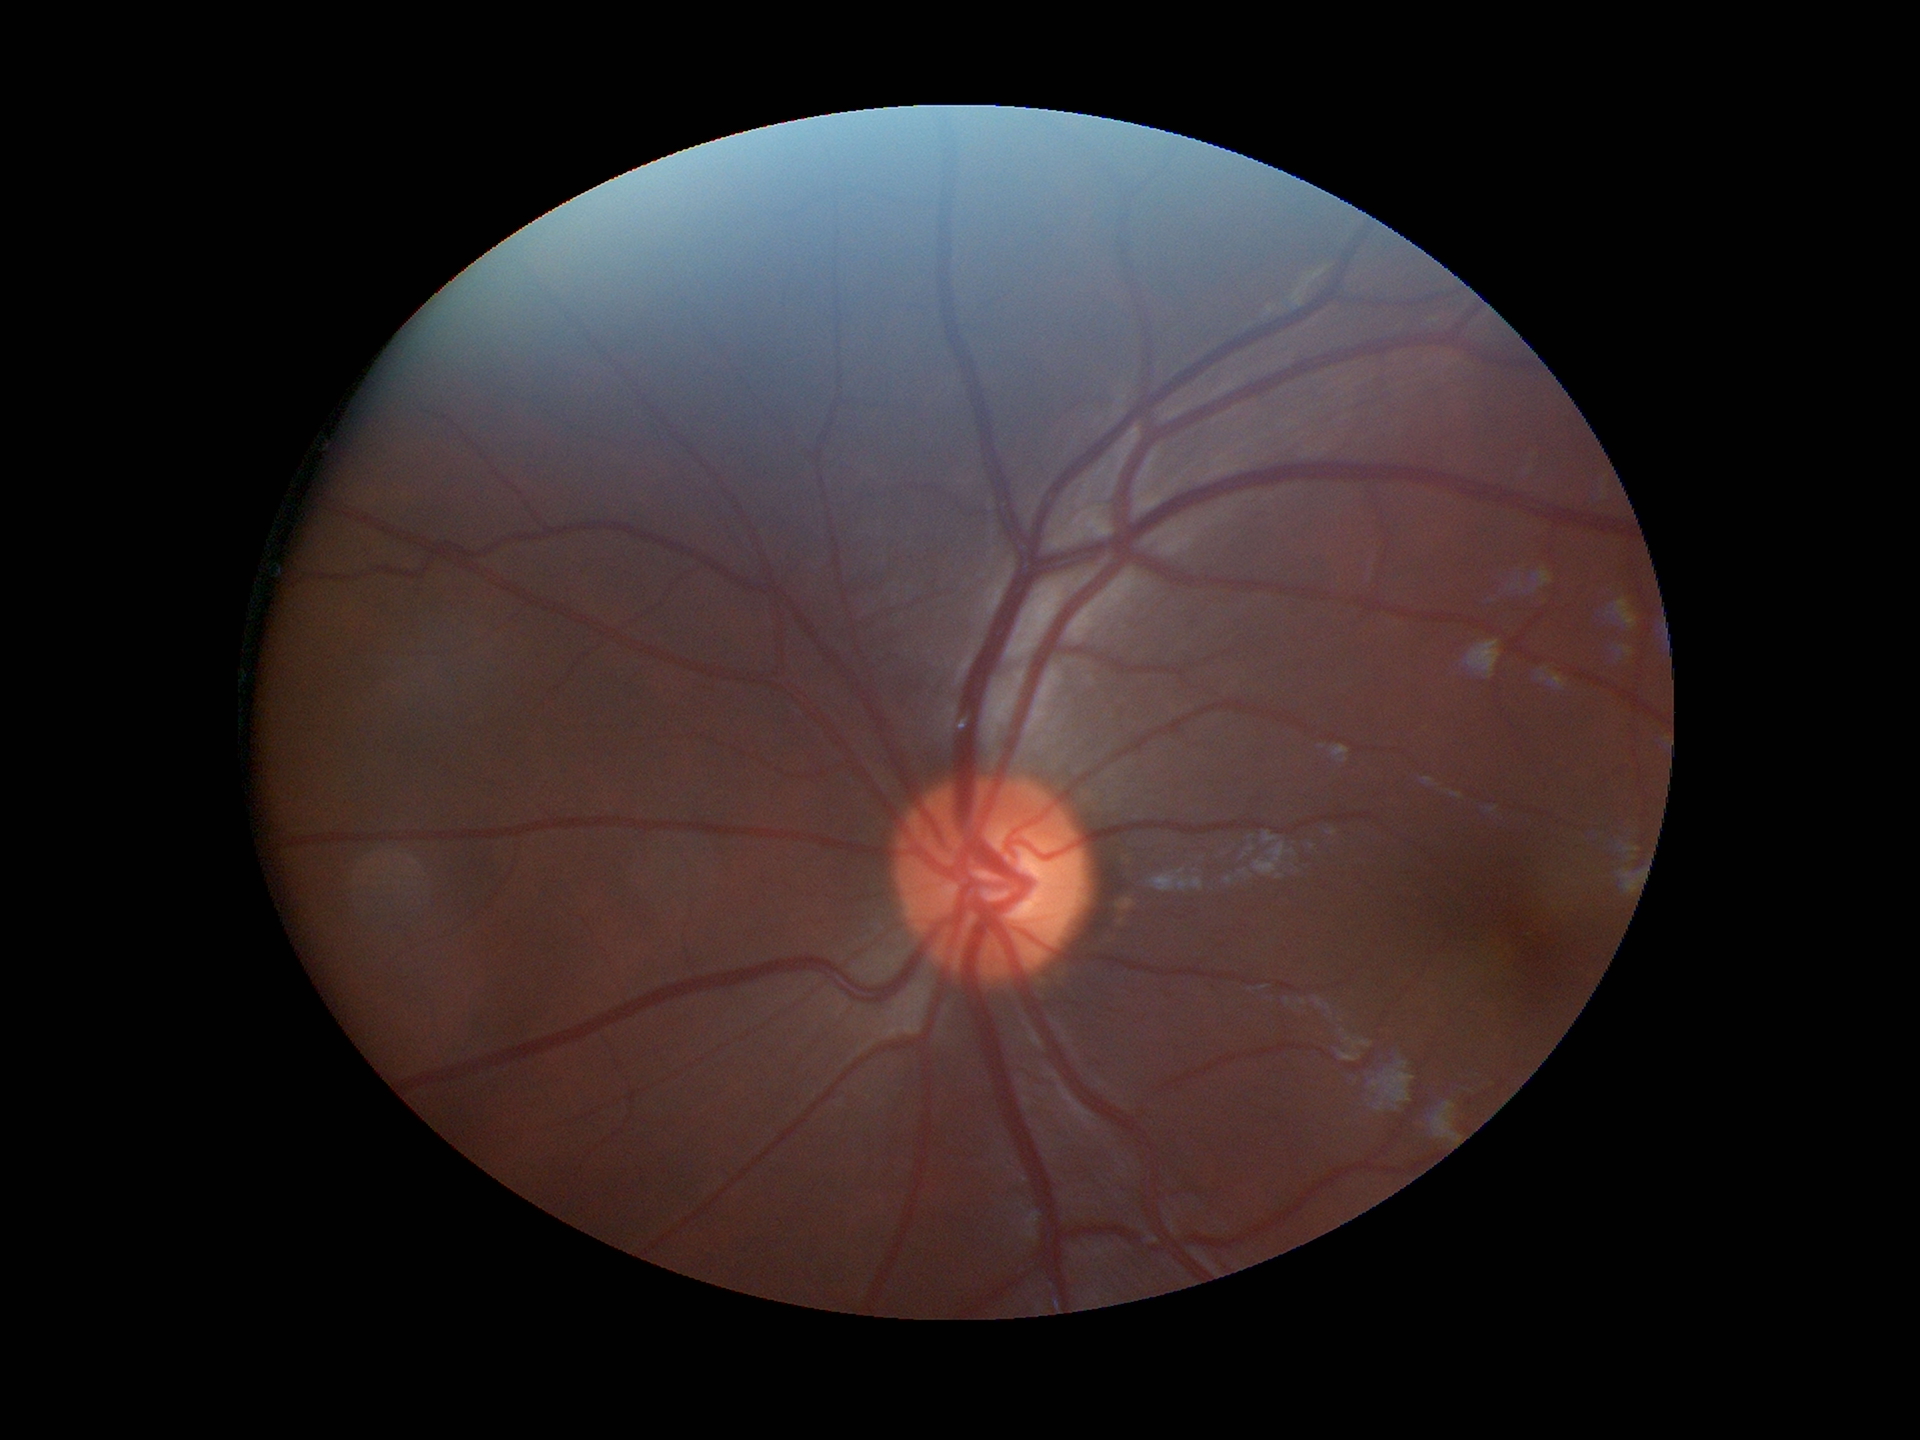

No evidence of glaucoma.
Vertical C/D ratio is 0.49.